740 by 721 pixels
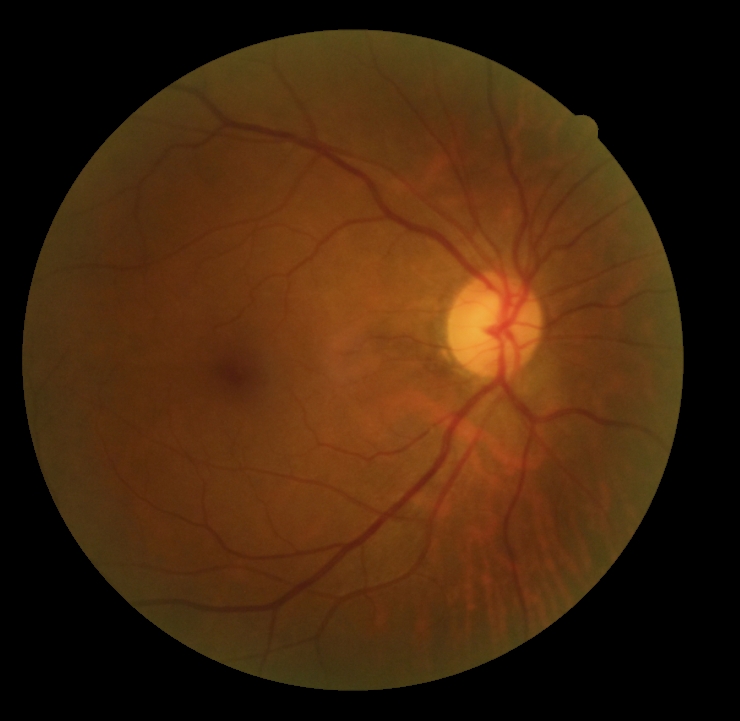
DR impression: negative for DR
DR stage: 0/4